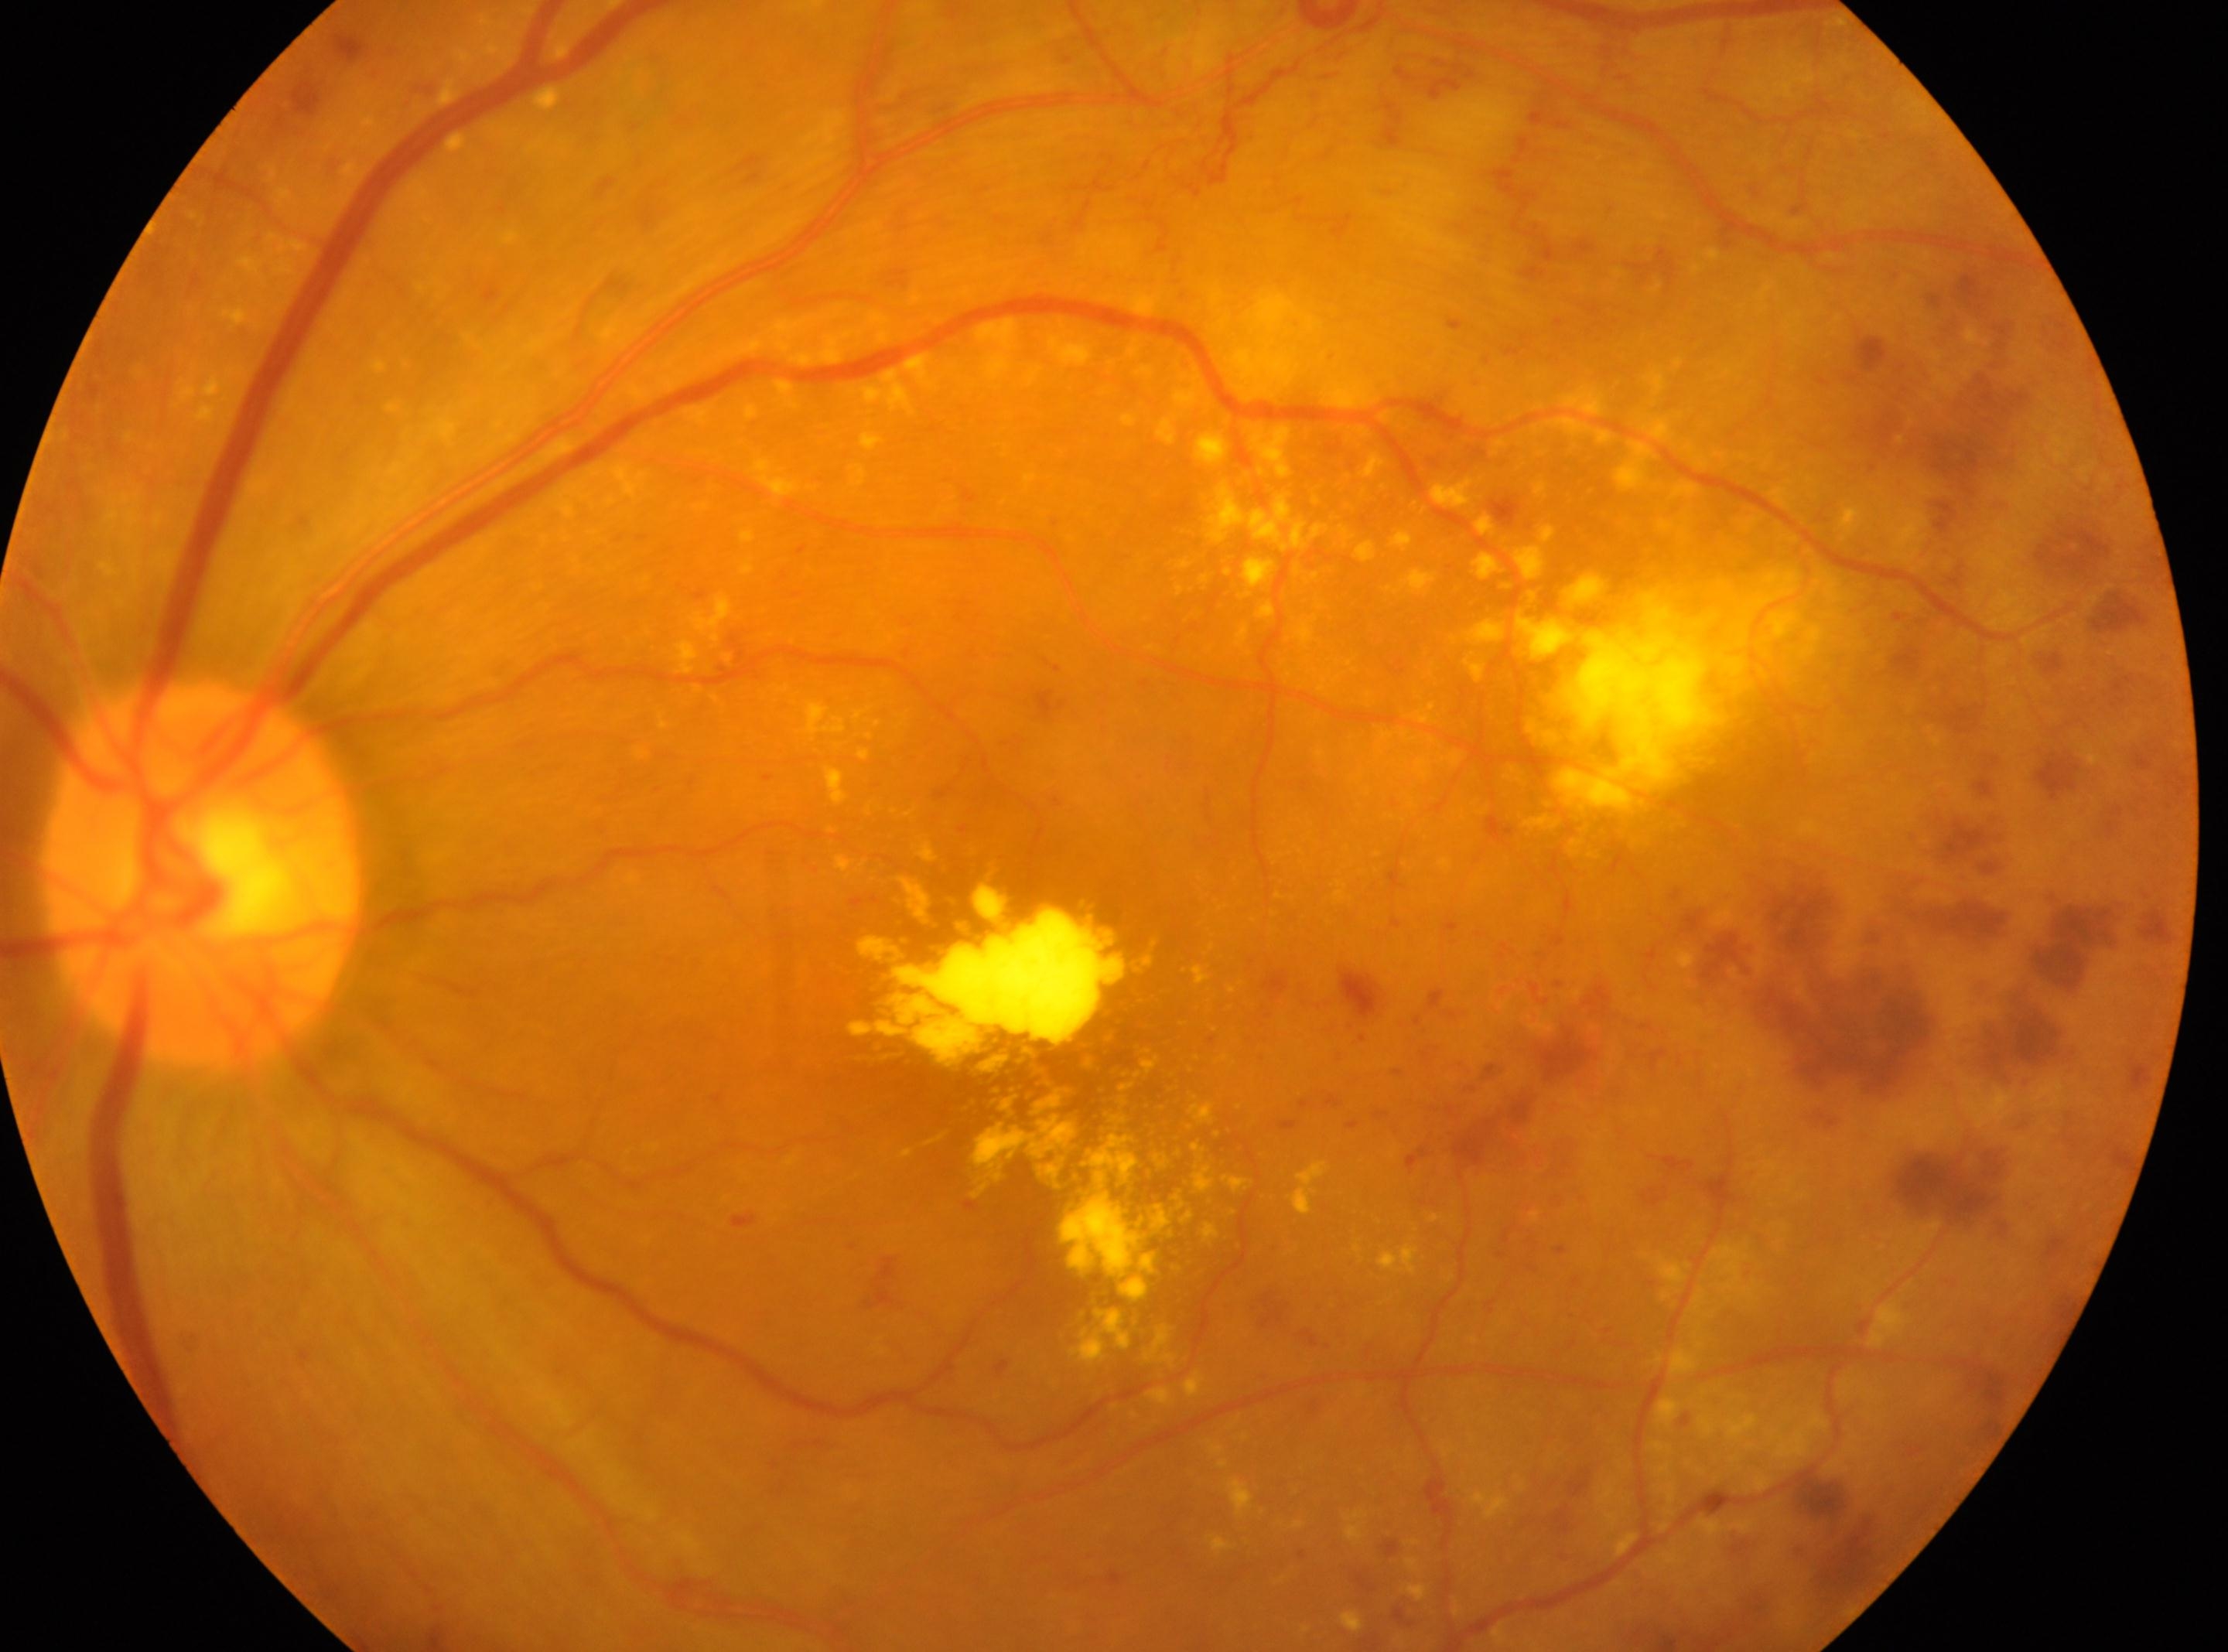
{
  "dr_grade": "4",
  "eye": "the left eye",
  "fovea": "[1086, 1080]",
  "optic_disc": "[199, 874]"
}